Nonmydriatic:
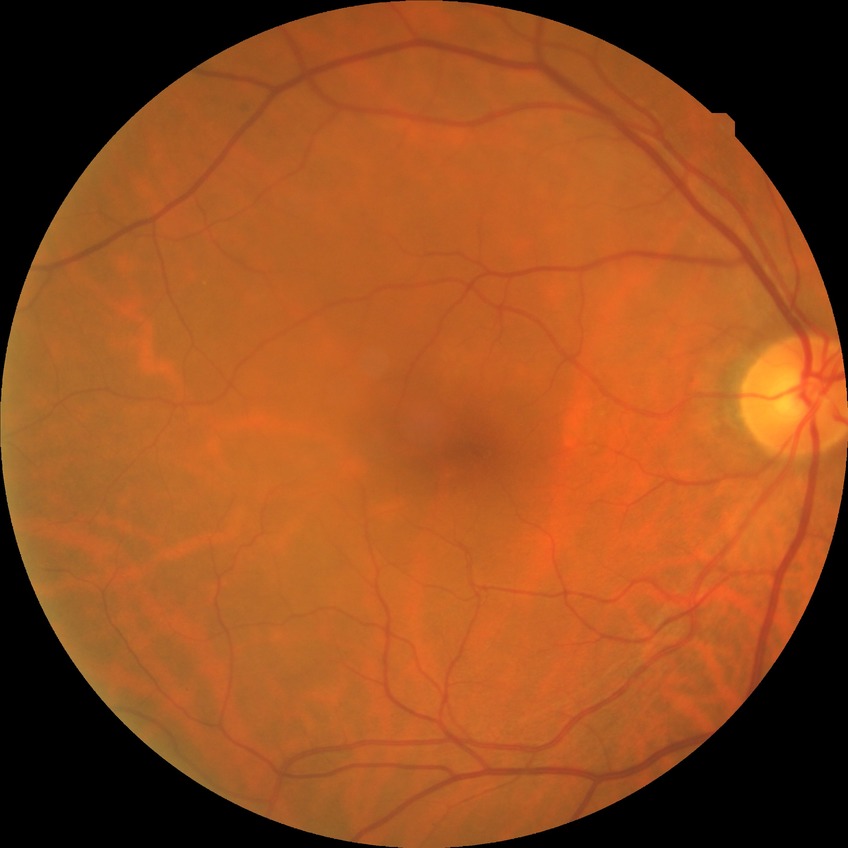

Diabetic retinopathy stage: no diabetic retinopathy.